Color fundus image, 512x512:
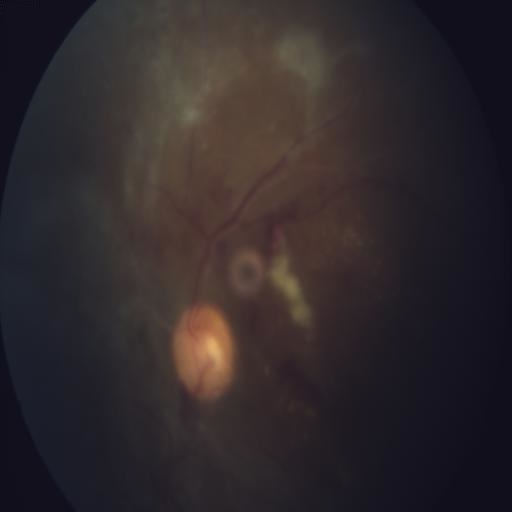 Impression: central retinal vein occlusion (CRVO) | media haze (MH) | cotton wool spots (CWS) | hemorrhagic retinopathy (HR).